Without pupil dilation, retinal fundus photograph:
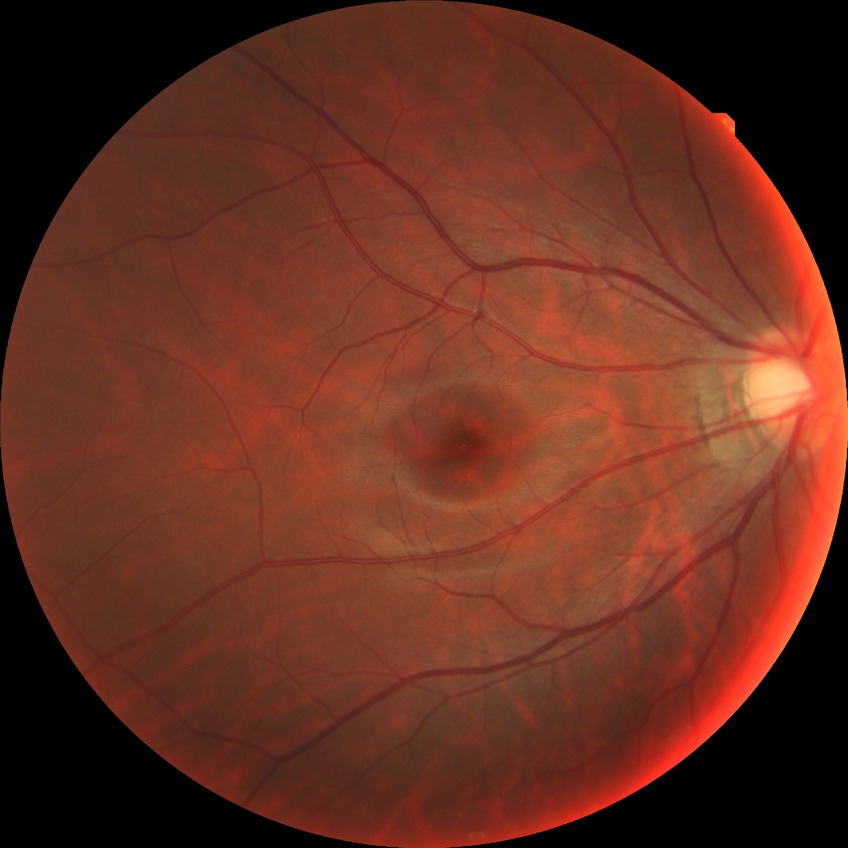

{"davis_grade": "NDR"}